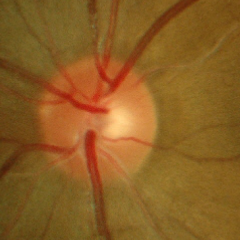
Fundus appearance consistent with early-stage glaucoma.